Color fundus photograph: 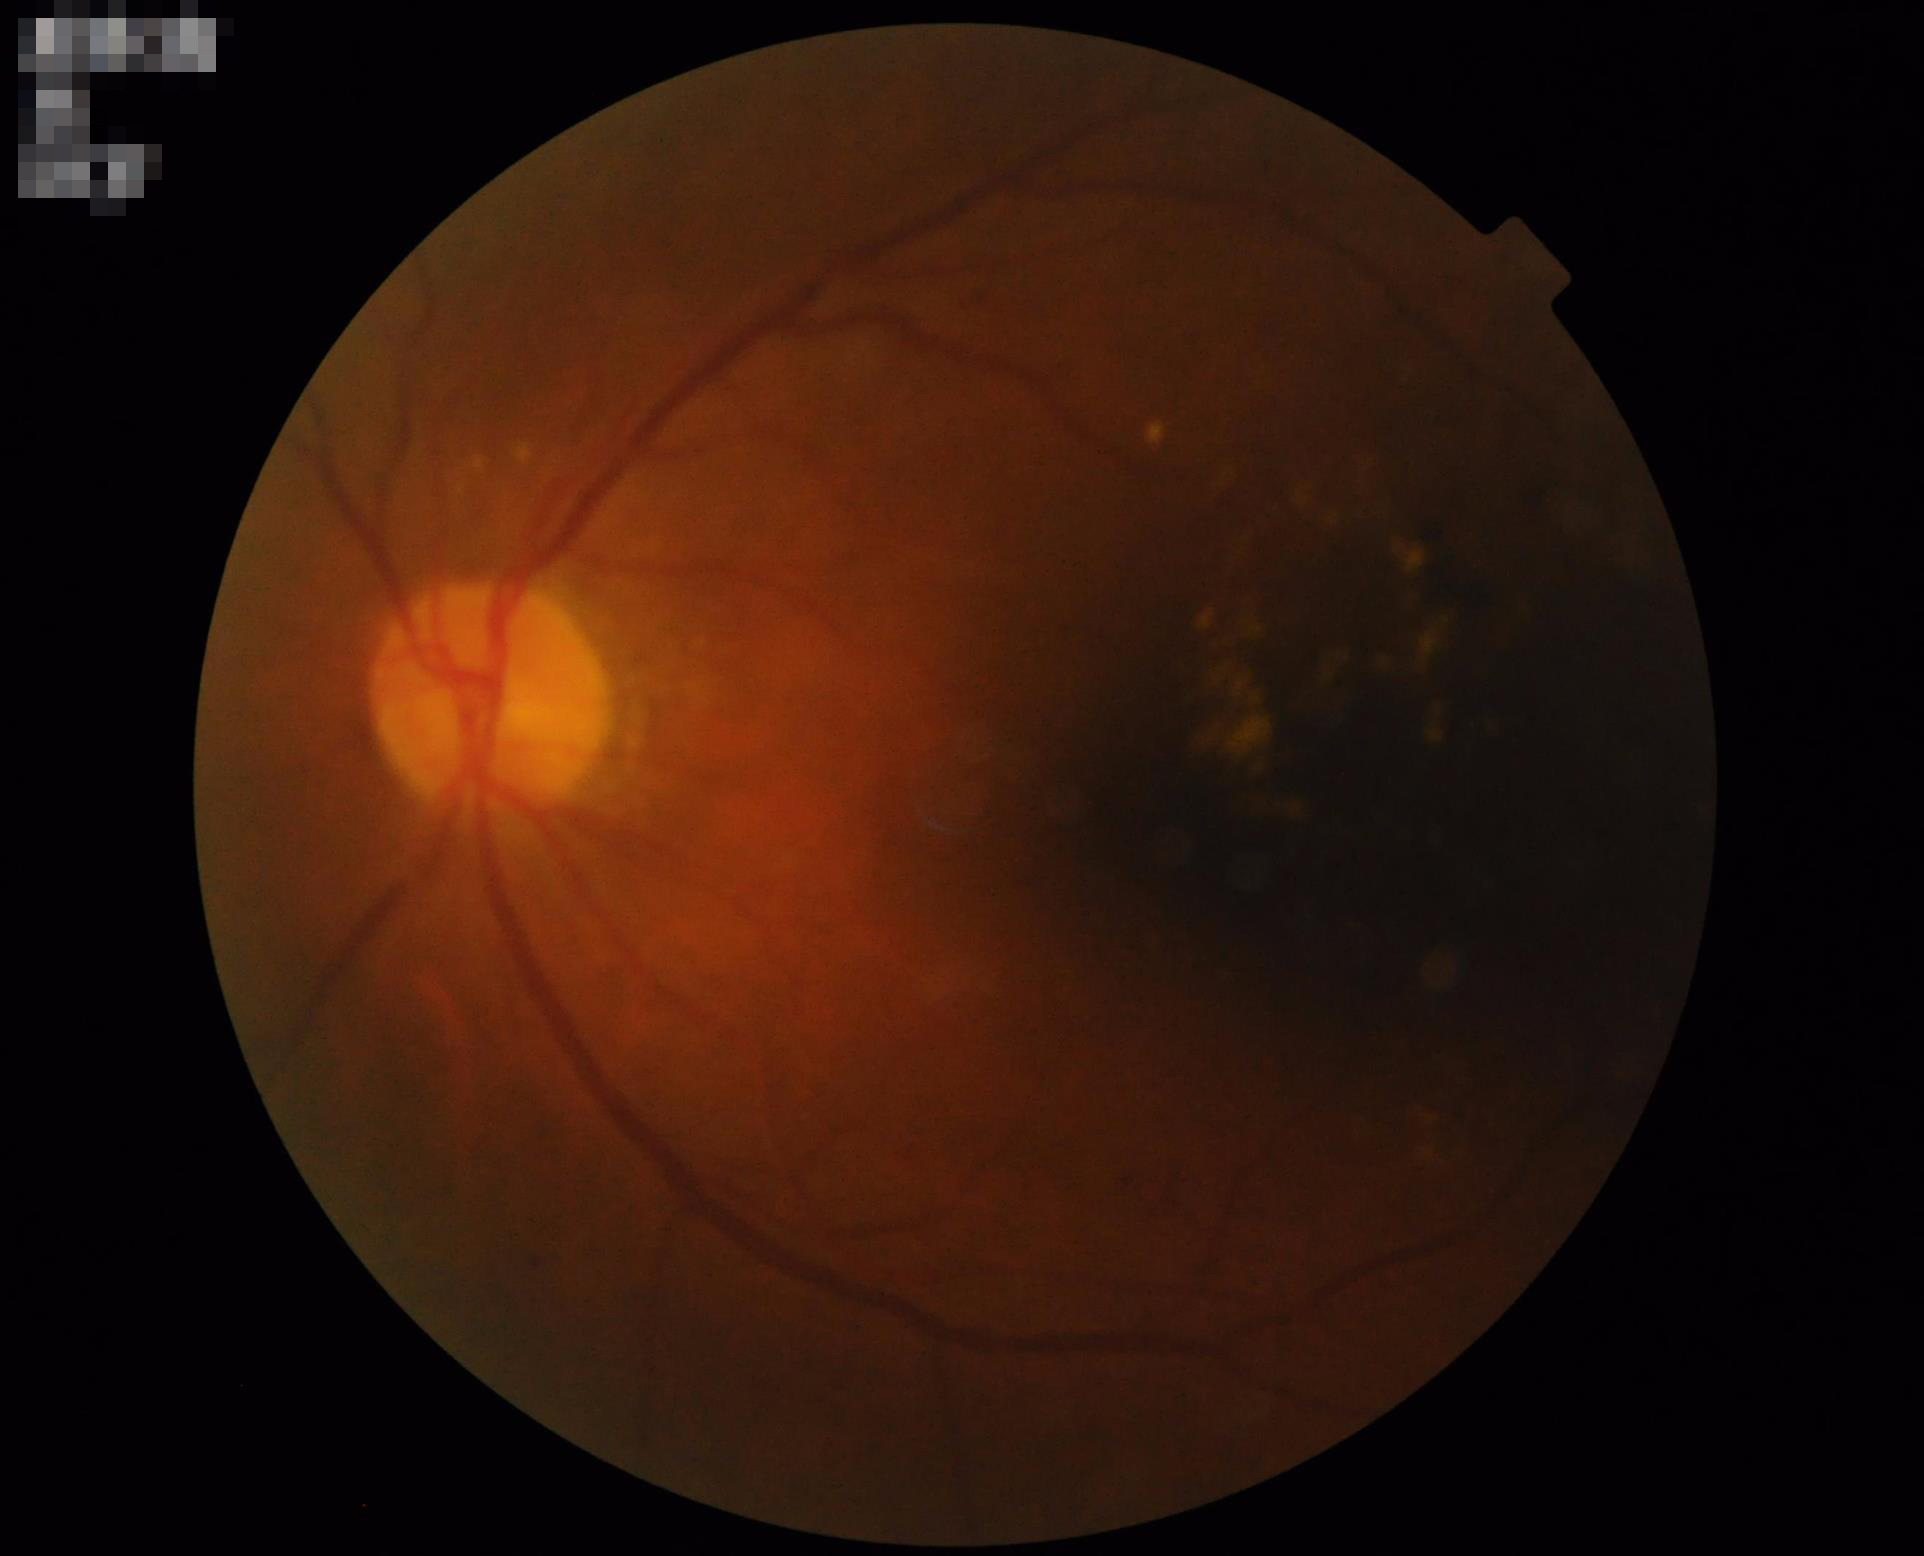 Narrow intensity range; structures are hard to distinguish. Image quality is inadequate for diagnostic use. Optic disc, vessels, and background are in focus. There is over- or under-exposure or a color cast.